Diabetic retinopathy graded by the modified Davis classification: 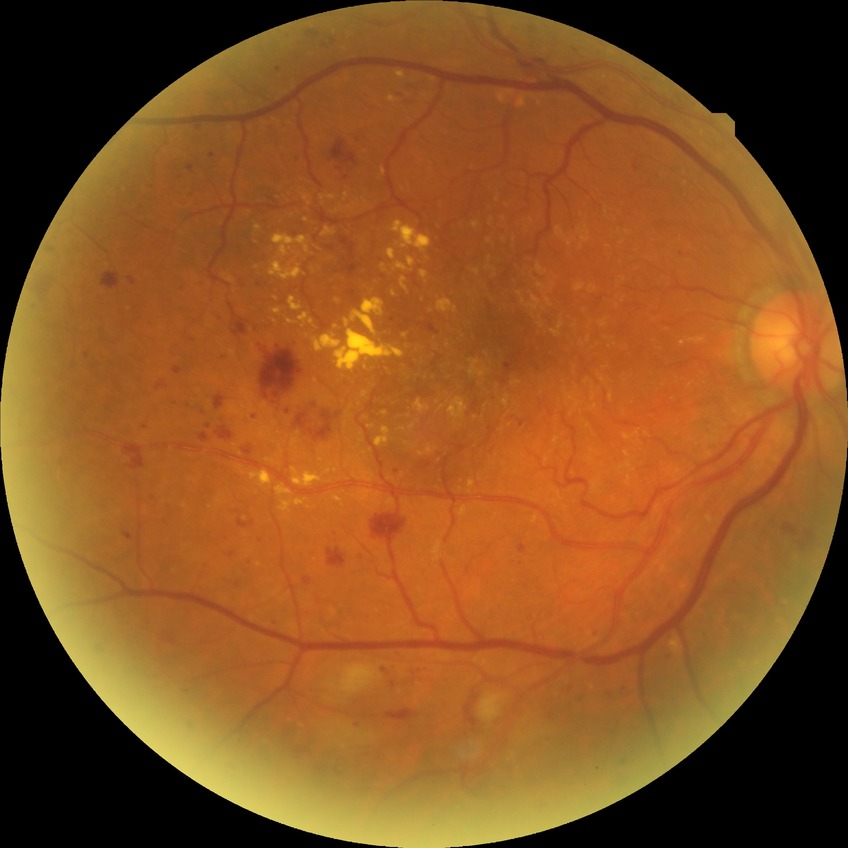

Modified Davis grading is pre-proliferative diabetic retinopathy.